Pediatric retinal photograph (wide-field). Phoenix ICON, 100° FOV. Image size 1240x1240:
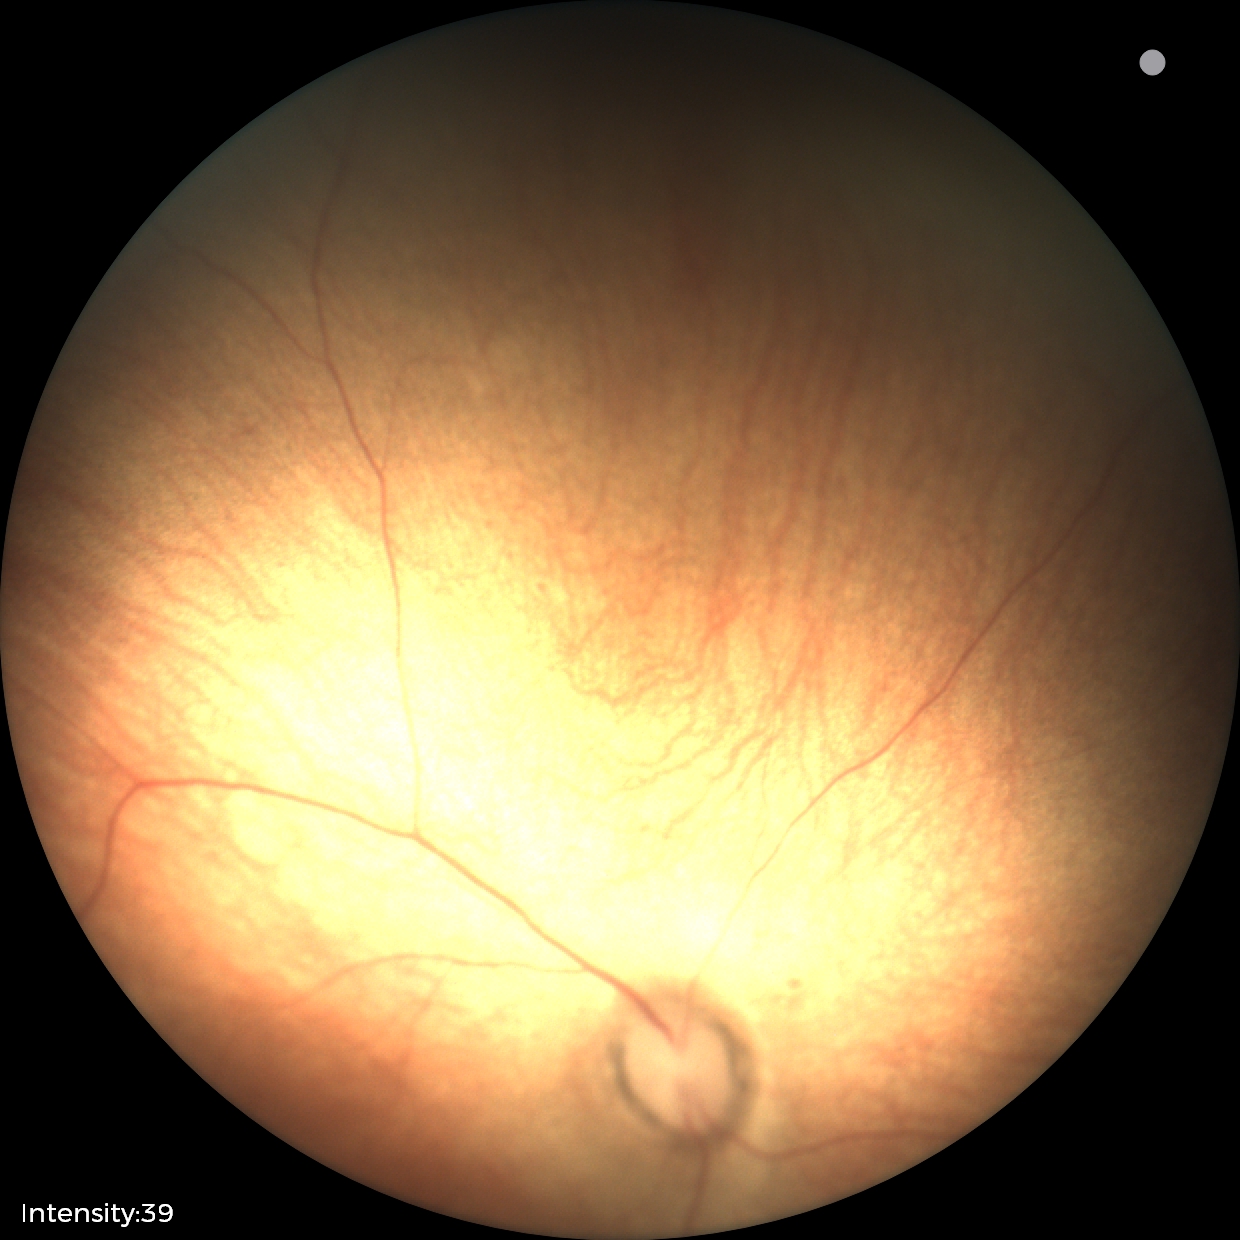 Screening examination diagnosed as physiological.